Pediatric wide-field fundus photograph. 640 by 480 pixels
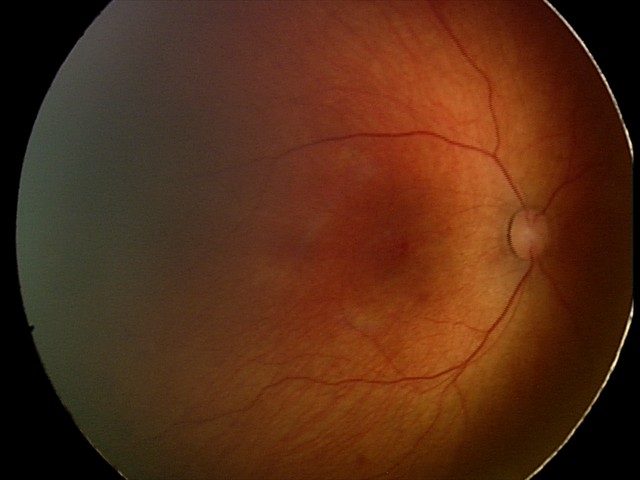

Screening: retinal hemorrhages.